2352x1568 · retinal fundus photograph
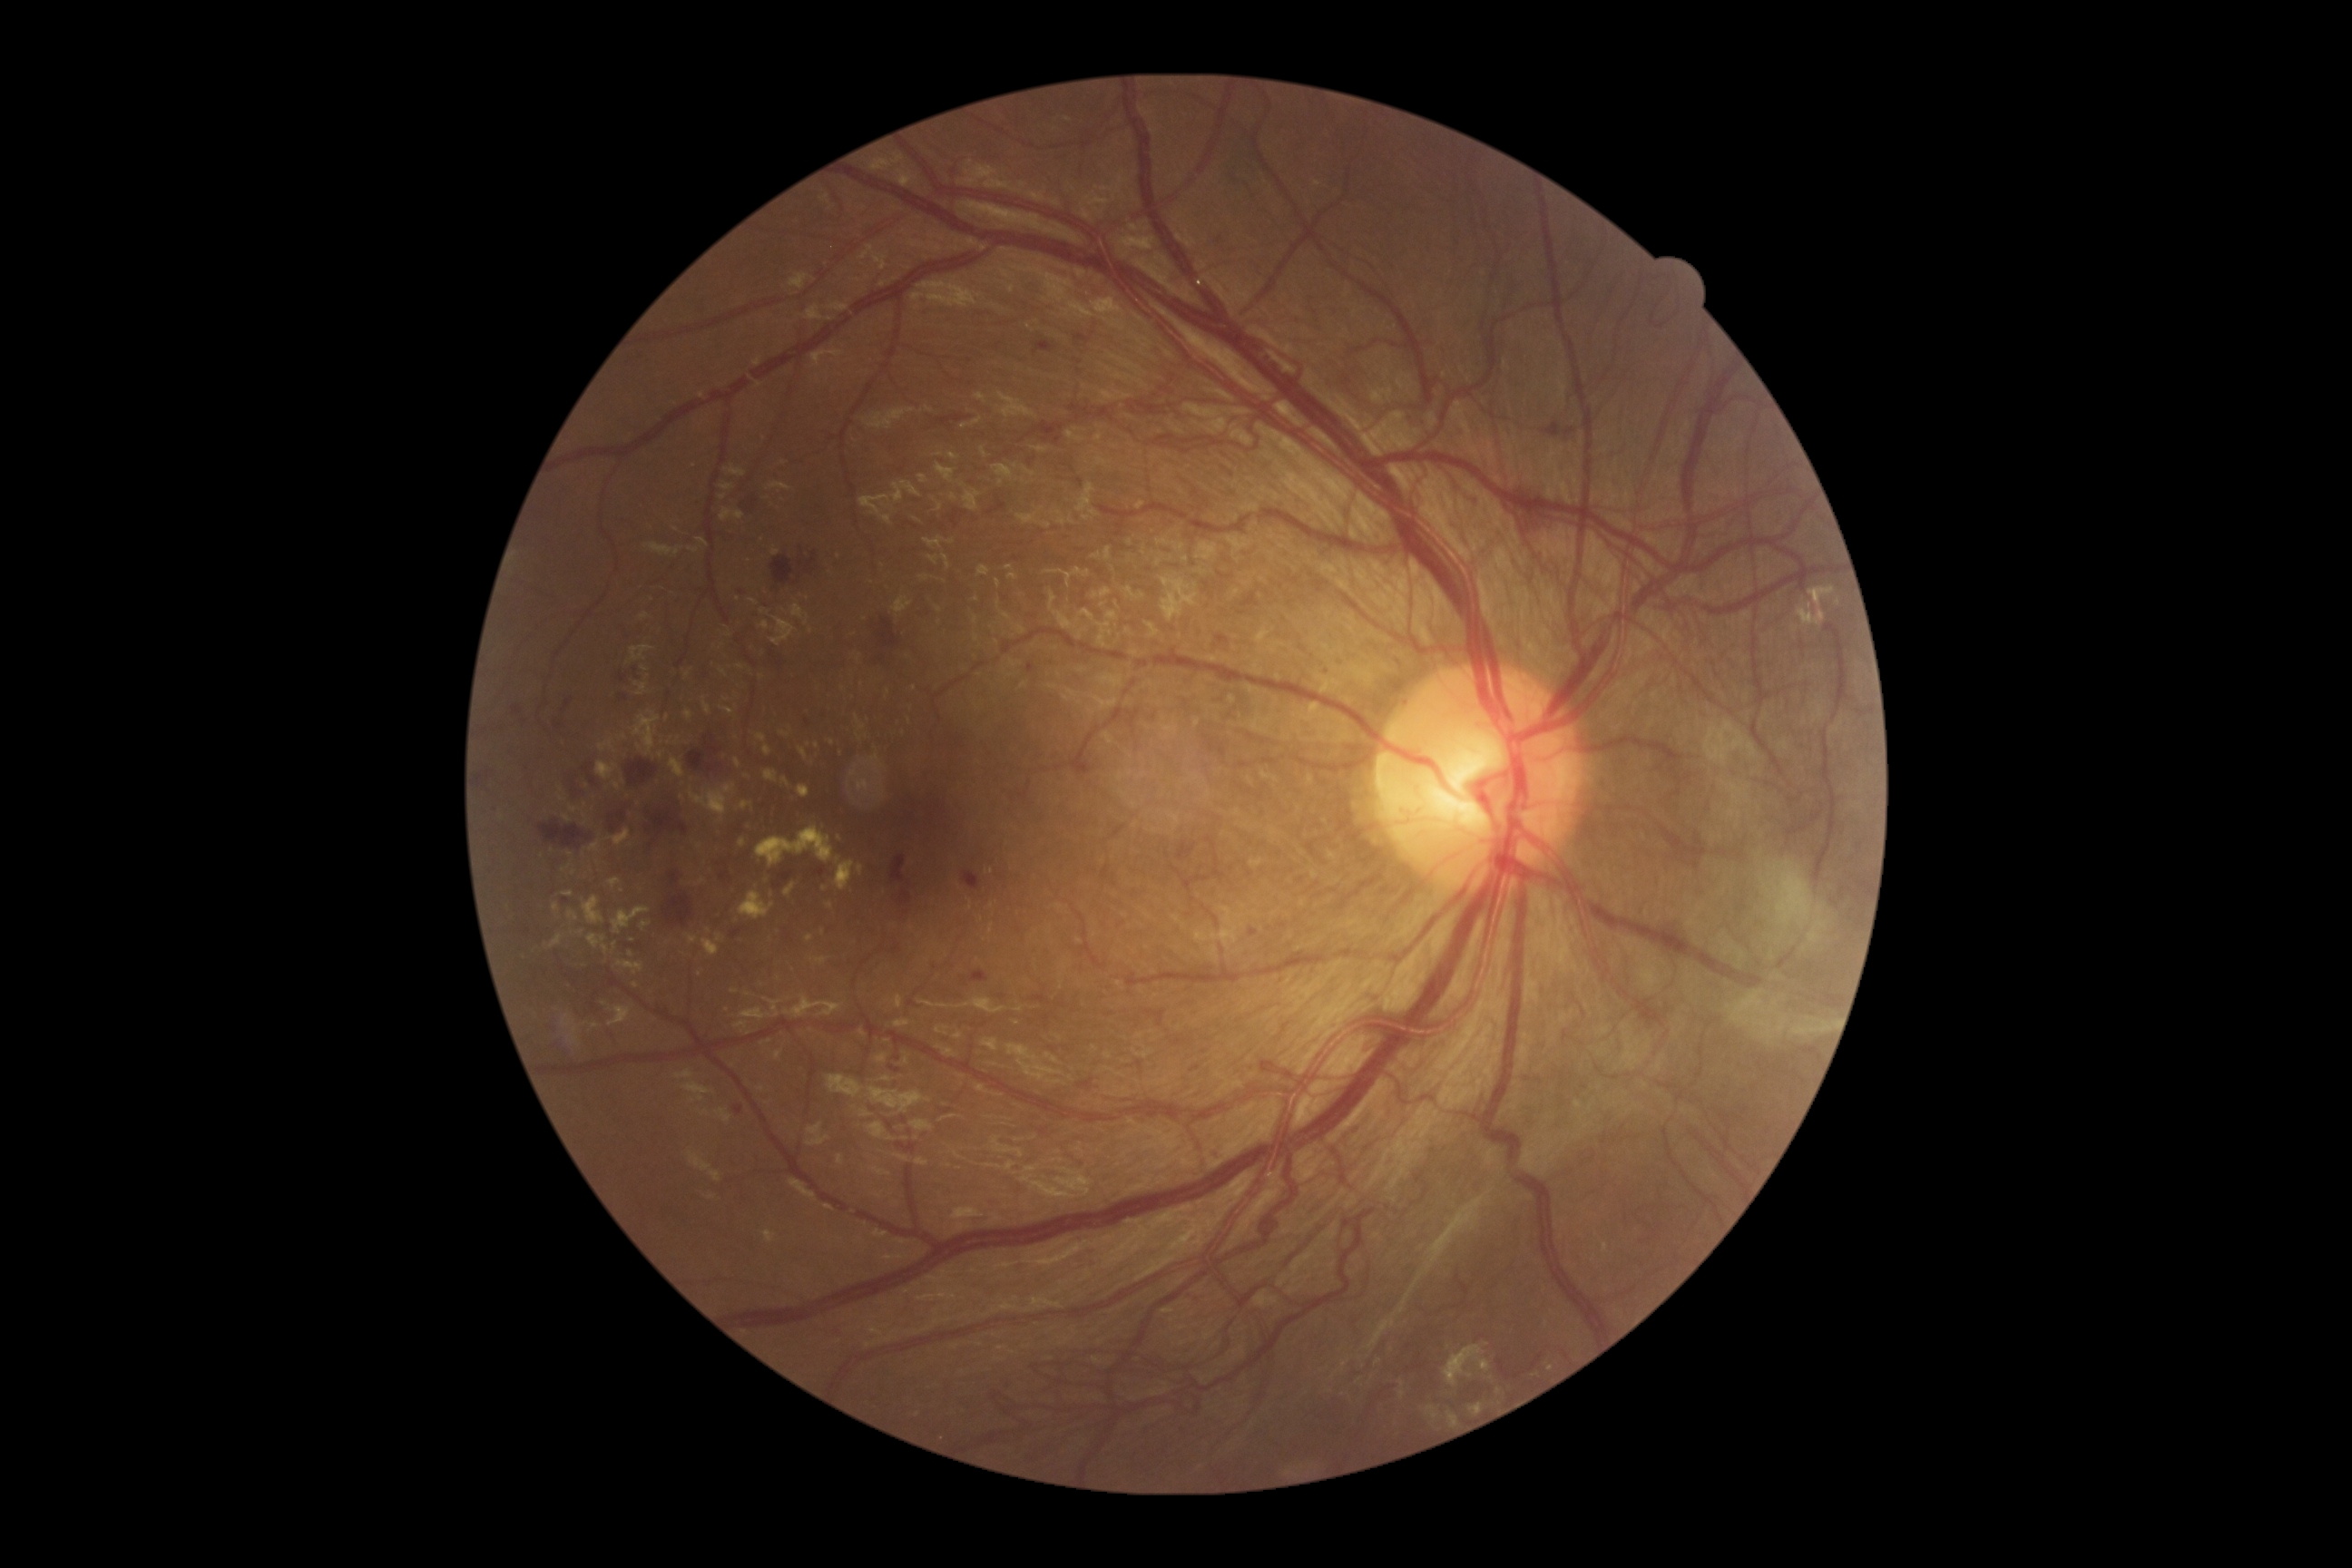

Diabetic retinopathy is 4/4.
Hard exudates include lesions at {"left": 612, "top": 908, "right": 651, "bottom": 936} | {"left": 609, "top": 879, "right": 622, "bottom": 888} | {"left": 589, "top": 934, "right": 609, "bottom": 954} | {"left": 721, "top": 707, "right": 736, "bottom": 716} | {"left": 716, "top": 934, "right": 725, "bottom": 943} | {"left": 720, "top": 509, "right": 745, "bottom": 522} | {"left": 734, "top": 760, "right": 741, "bottom": 769} | {"left": 685, "top": 710, "right": 692, "bottom": 721} | {"left": 636, "top": 683, "right": 649, "bottom": 696}.
Smaller hard exudates around Point(810, 939) | Point(699, 846) | Point(825, 889) | Point(722, 497) | Point(888, 692) | Point(605, 1004) | Point(830, 905) | Point(640, 747) | Point(1838, 602).